Graded on the modified Davis scale · 45° field of view
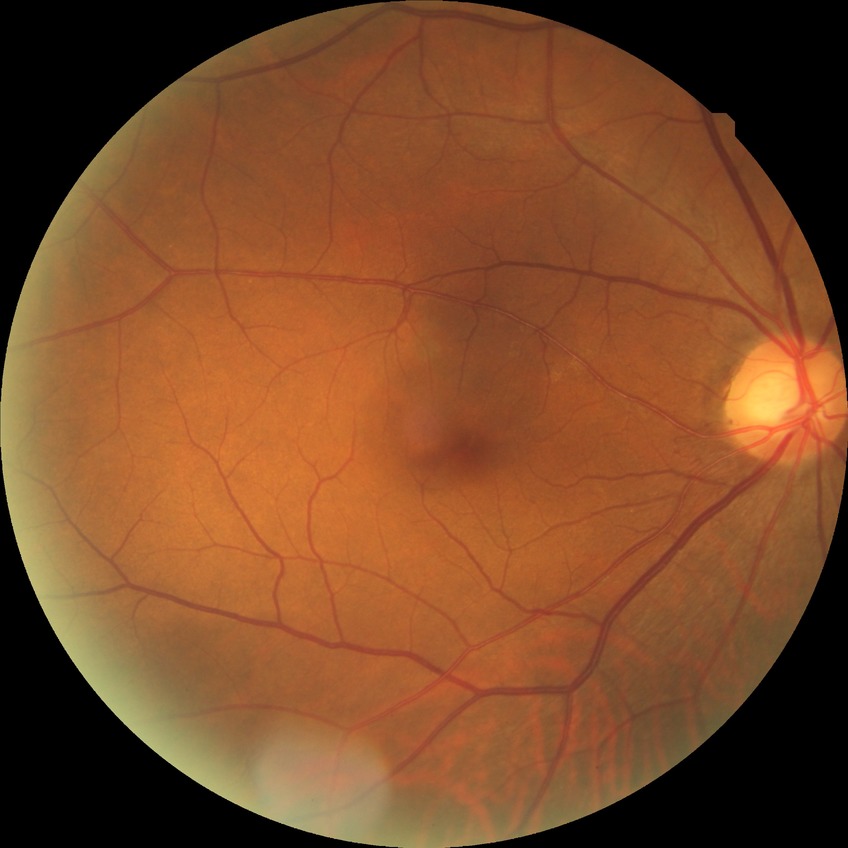
Diabetic retinopathy (DR) is no diabetic retinopathy (NDR).